Color fundus photograph from a handheld portable camera. Image size 2212x1659
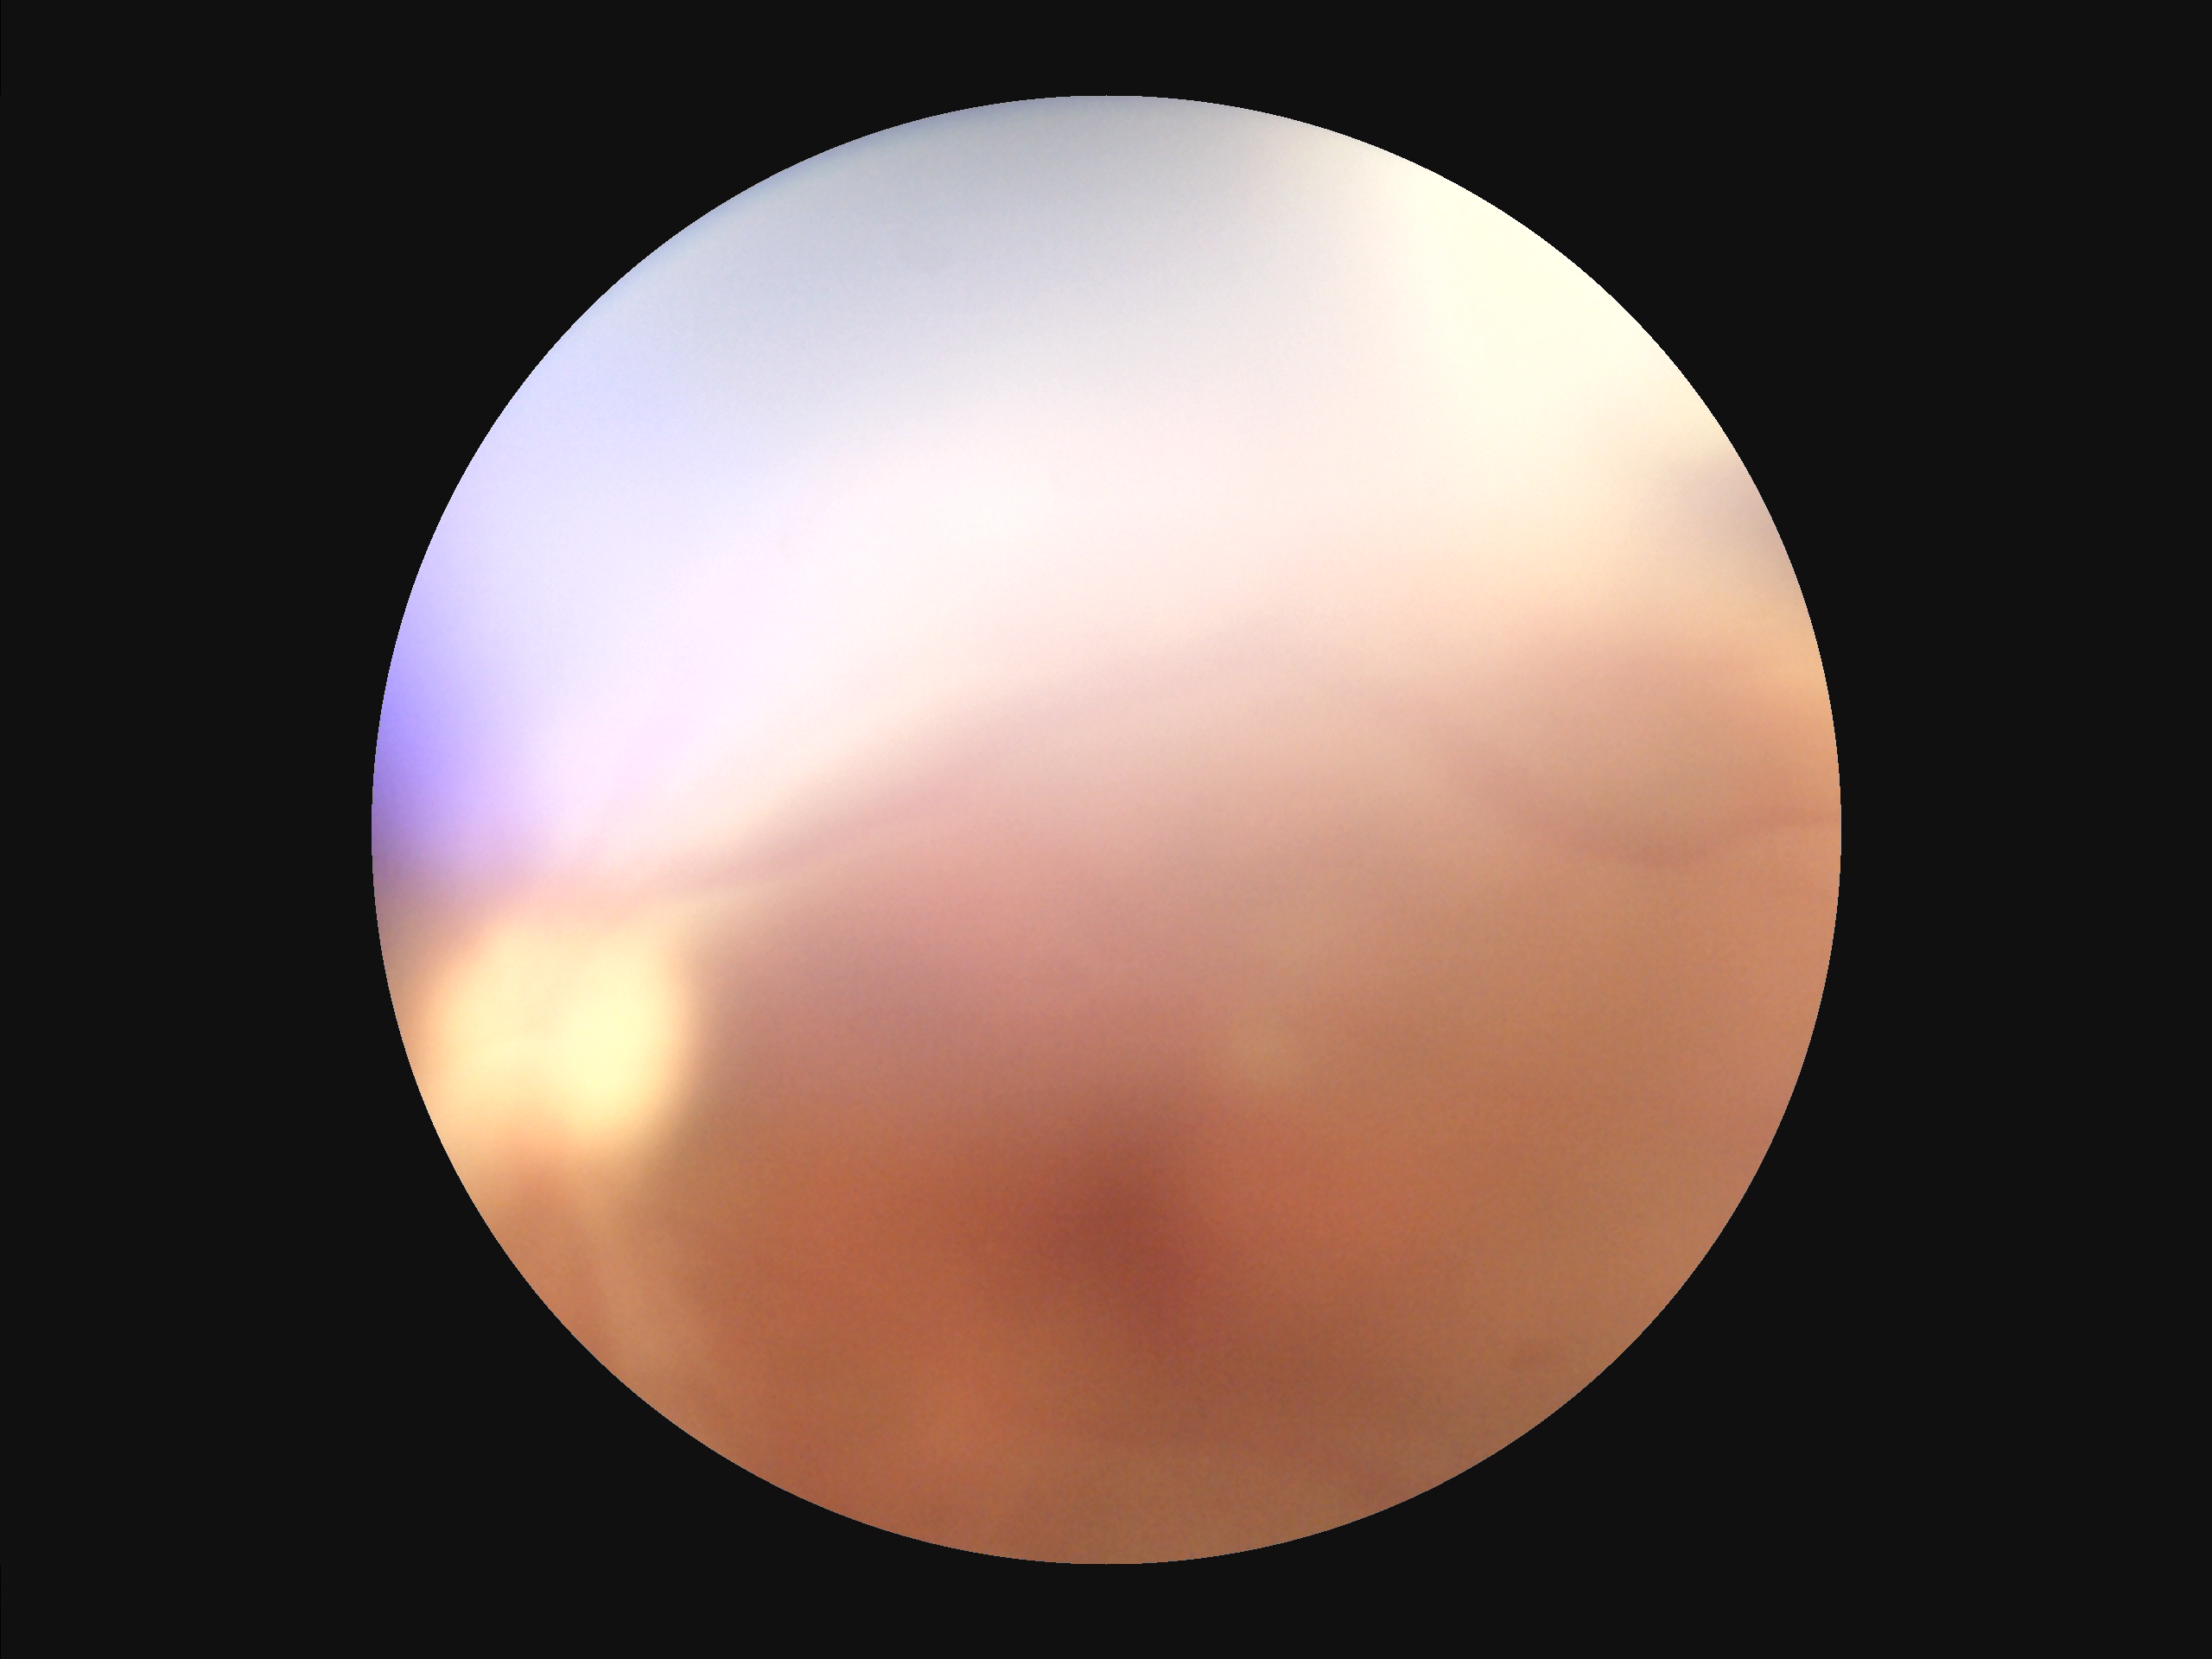
Illumination is uneven.
Noticeable blur in the optic disc, vessels, or background.
Overall image quality is poor.
Poor dynamic range.